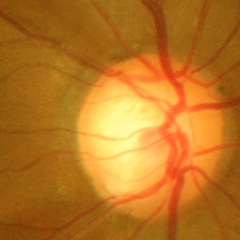 Fundus image with findings of advanced-stage glaucoma.